640x480; infant wide-field retinal image:
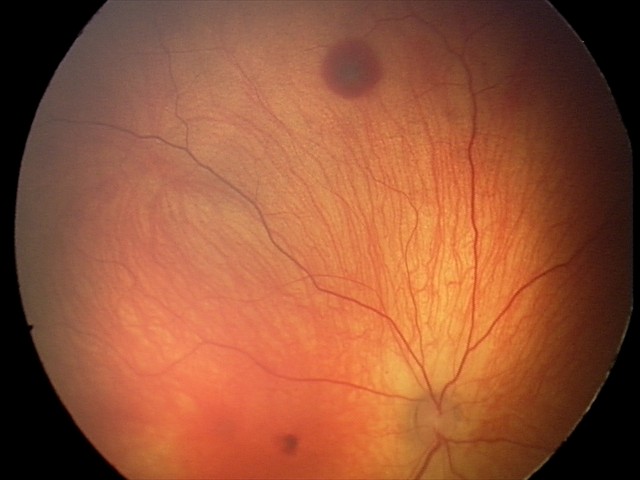 From an examination with diagnosis of retinal hemorrhages.